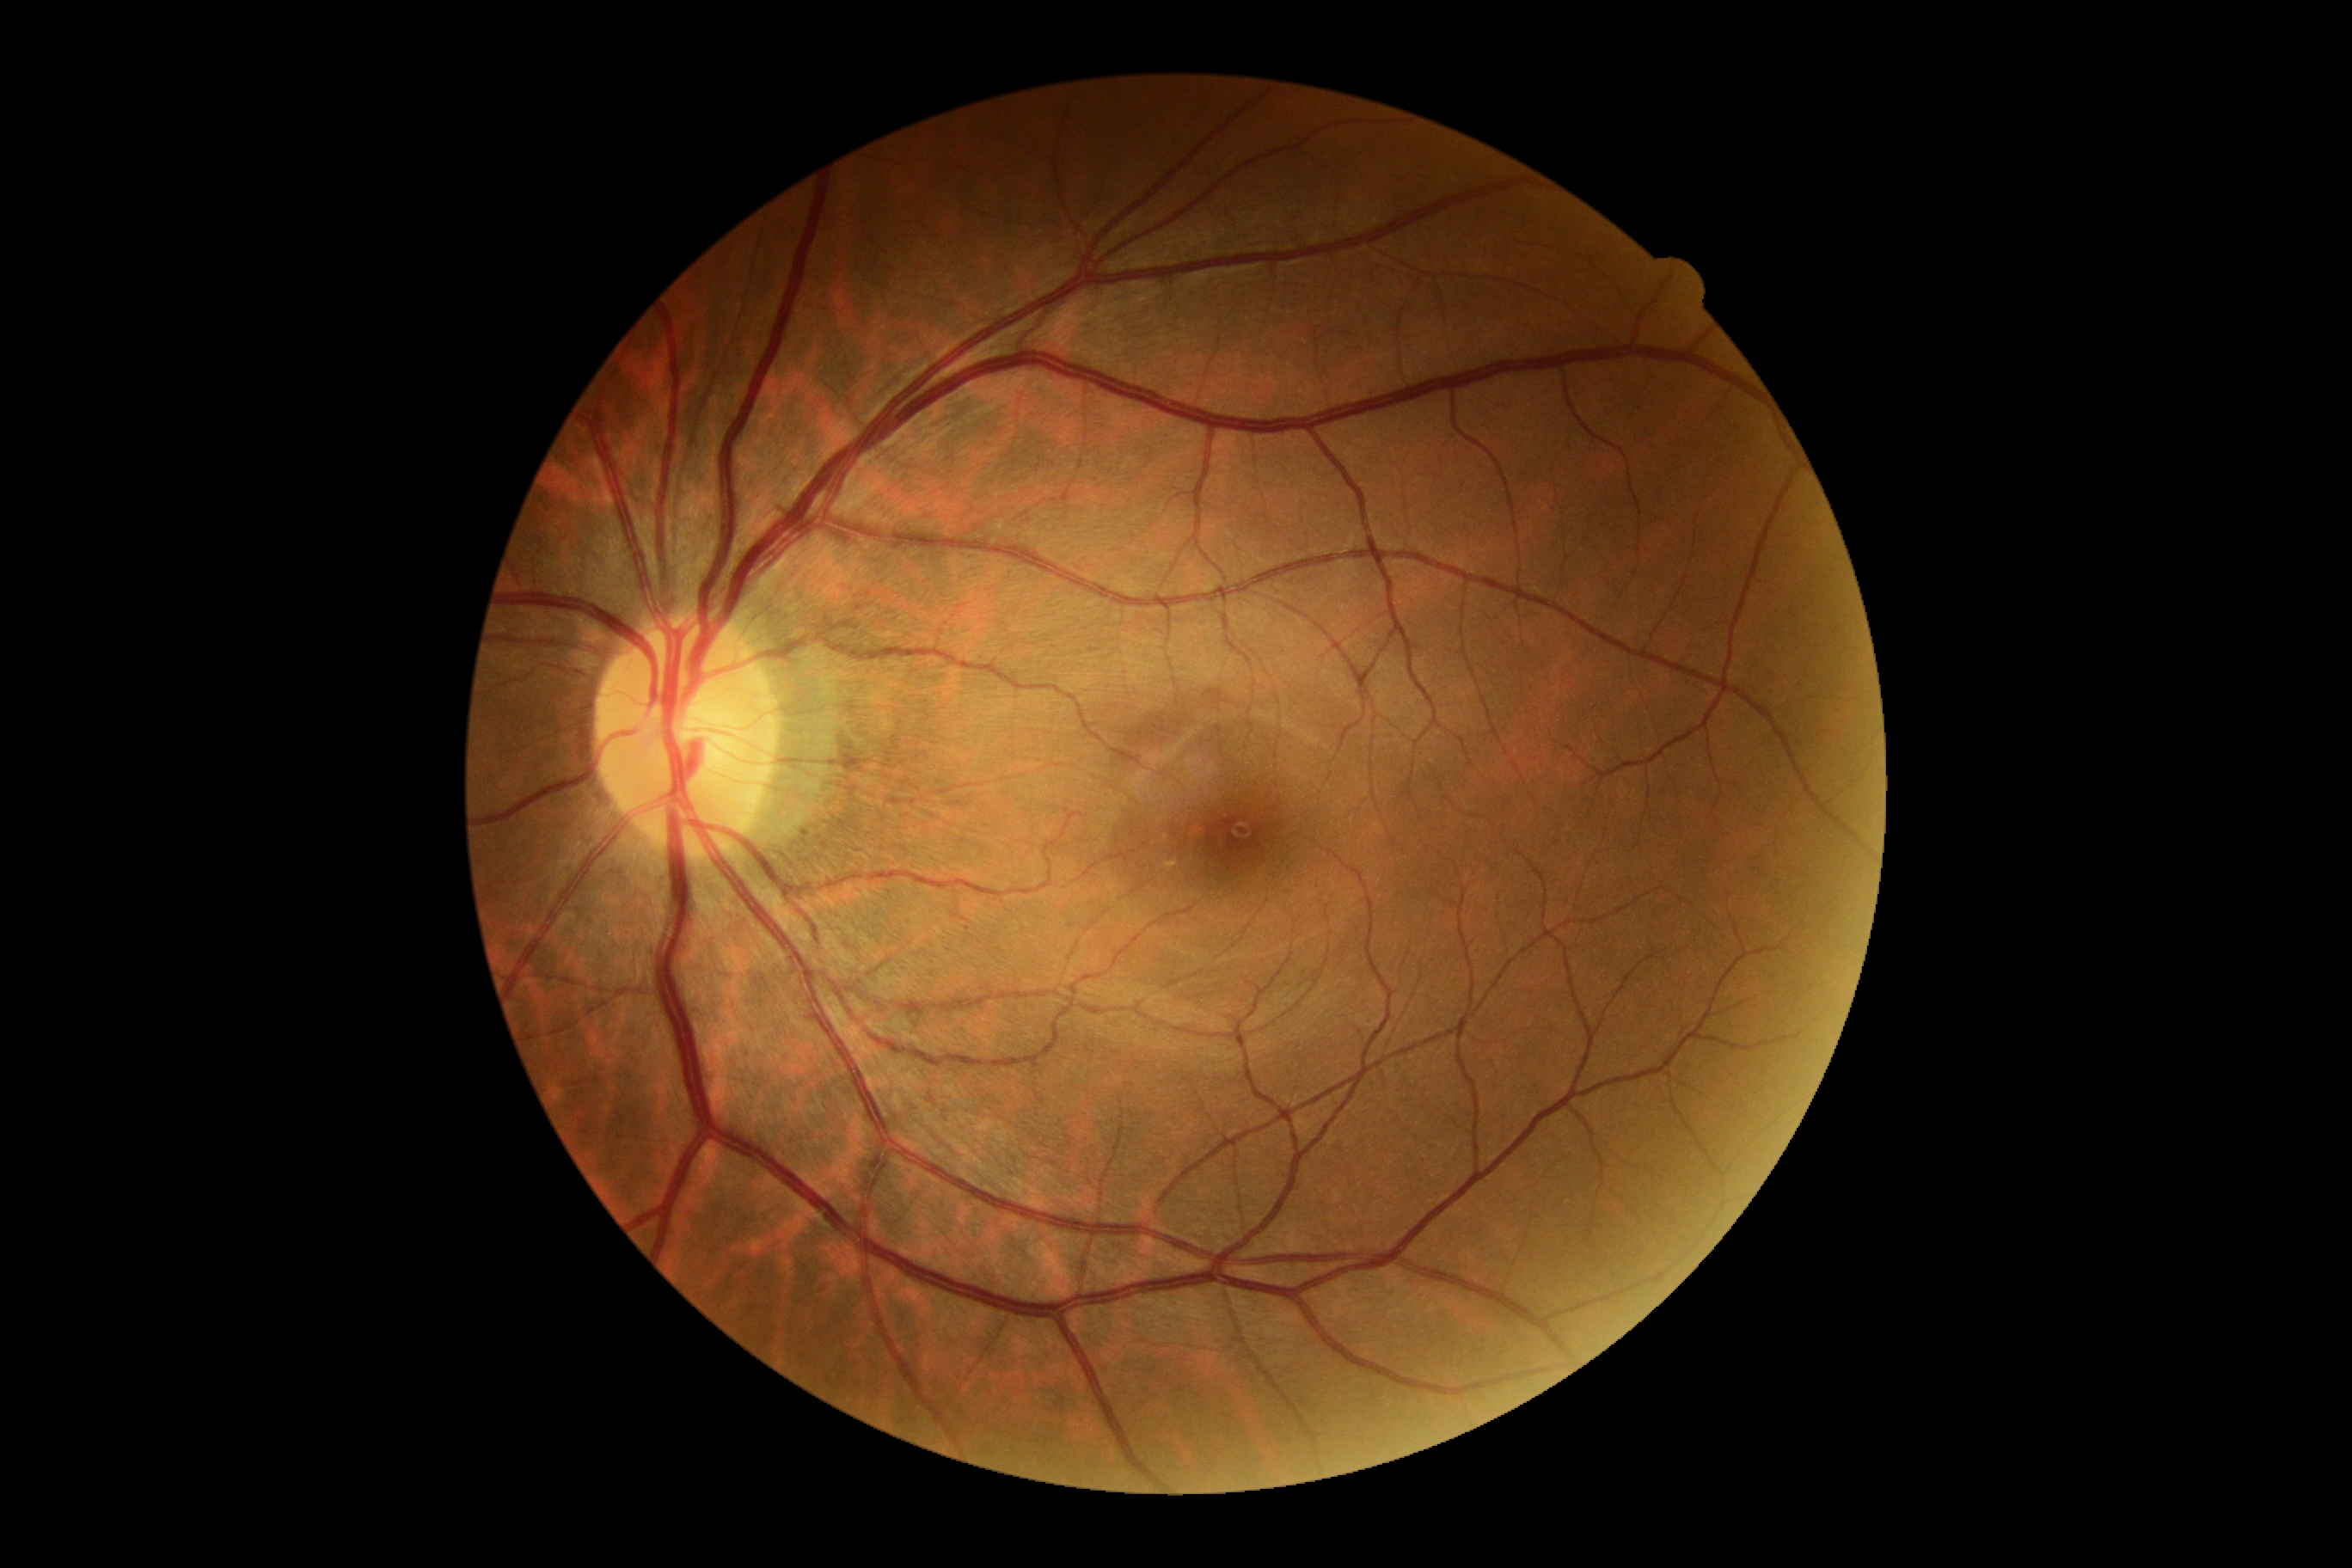 retinopathy grade = 0/4.